45 degree fundus photograph, 848 x 848 pixels — 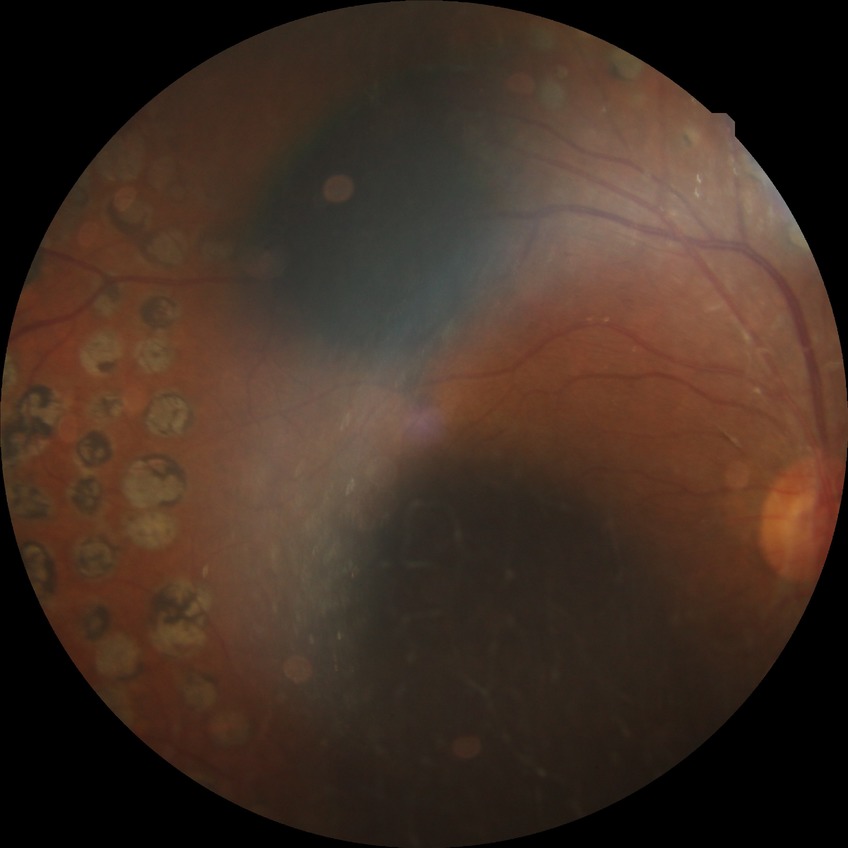

Diabetic retinopathy (DR) is proliferative diabetic retinopathy (PDR).